Image size 1240x1240; wide-field fundus photograph of an infant
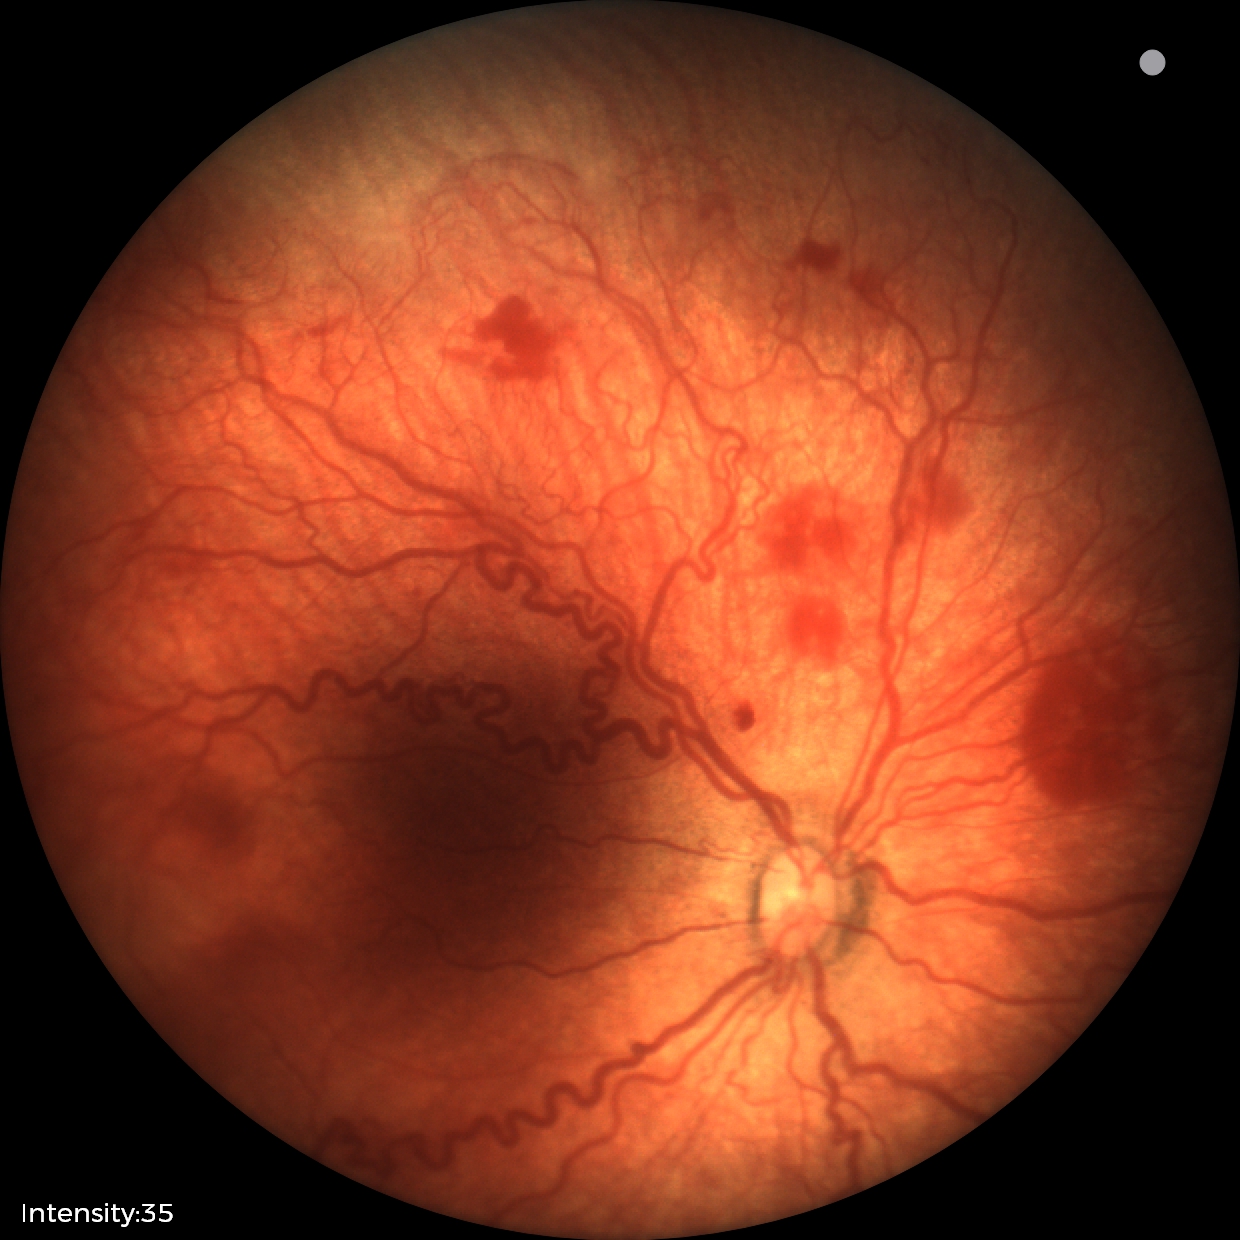
Assessment: retinopathy of prematurity (ROP) stage 2; plus disease — abnormal dilation and tortuosity of the posterior pole retinal vessels.